100° field of view (Phoenix ICON) · 1240 x 1240 pixels · pediatric wide-field fundus photograph.
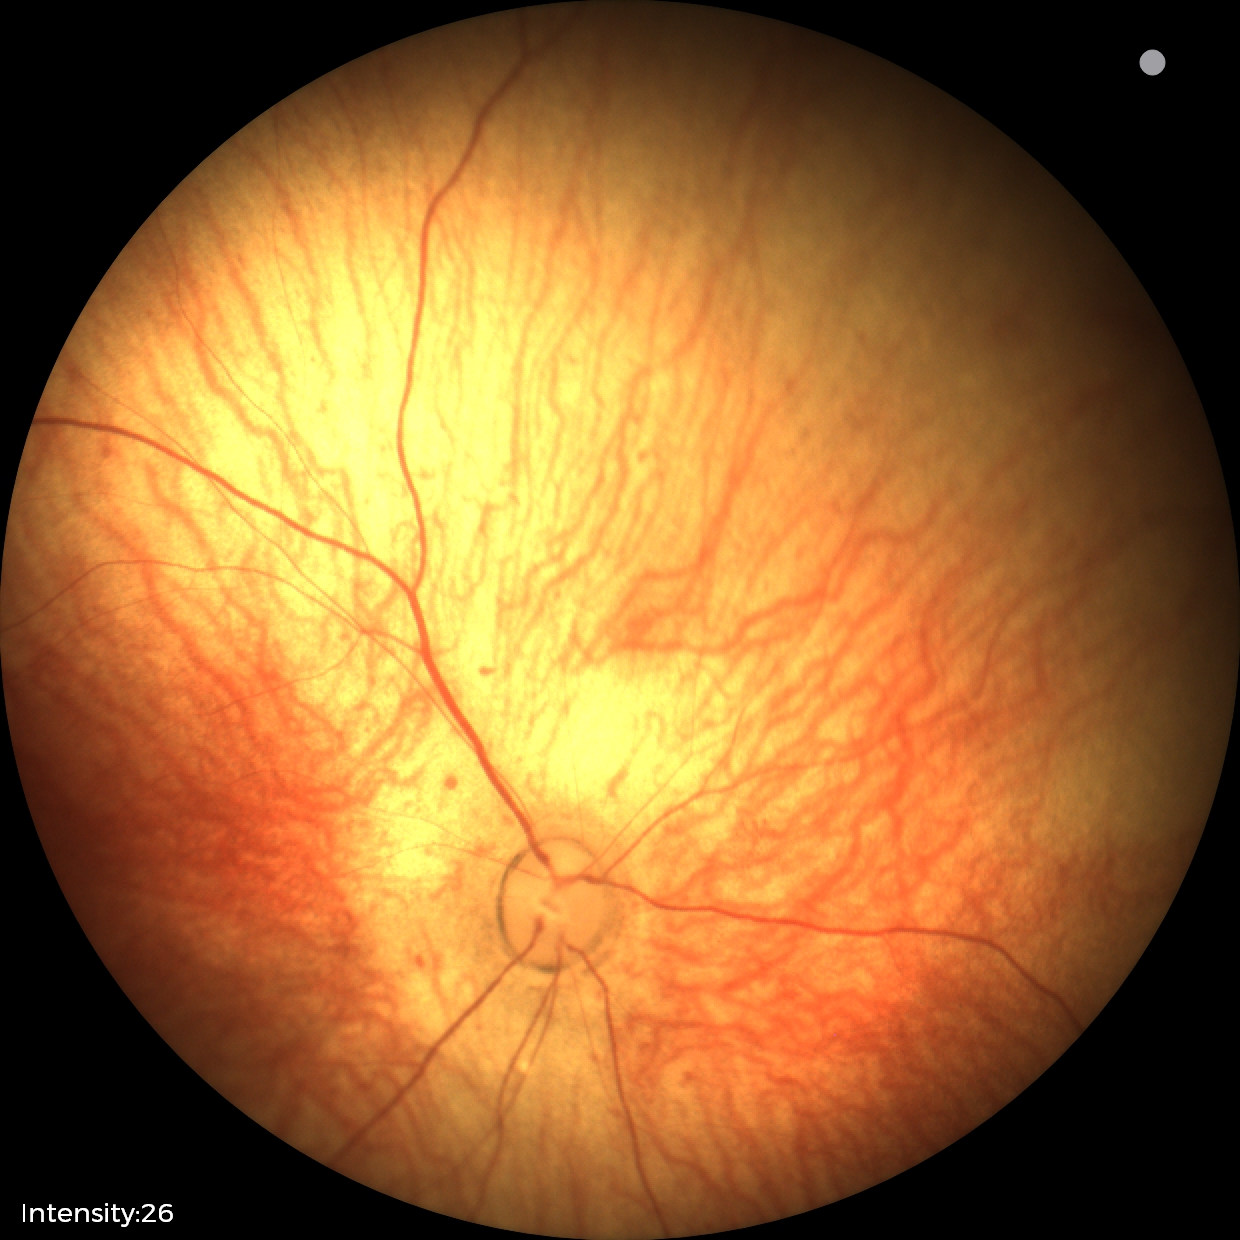 Diagnosis: no abnormalities